Posterior pole view — 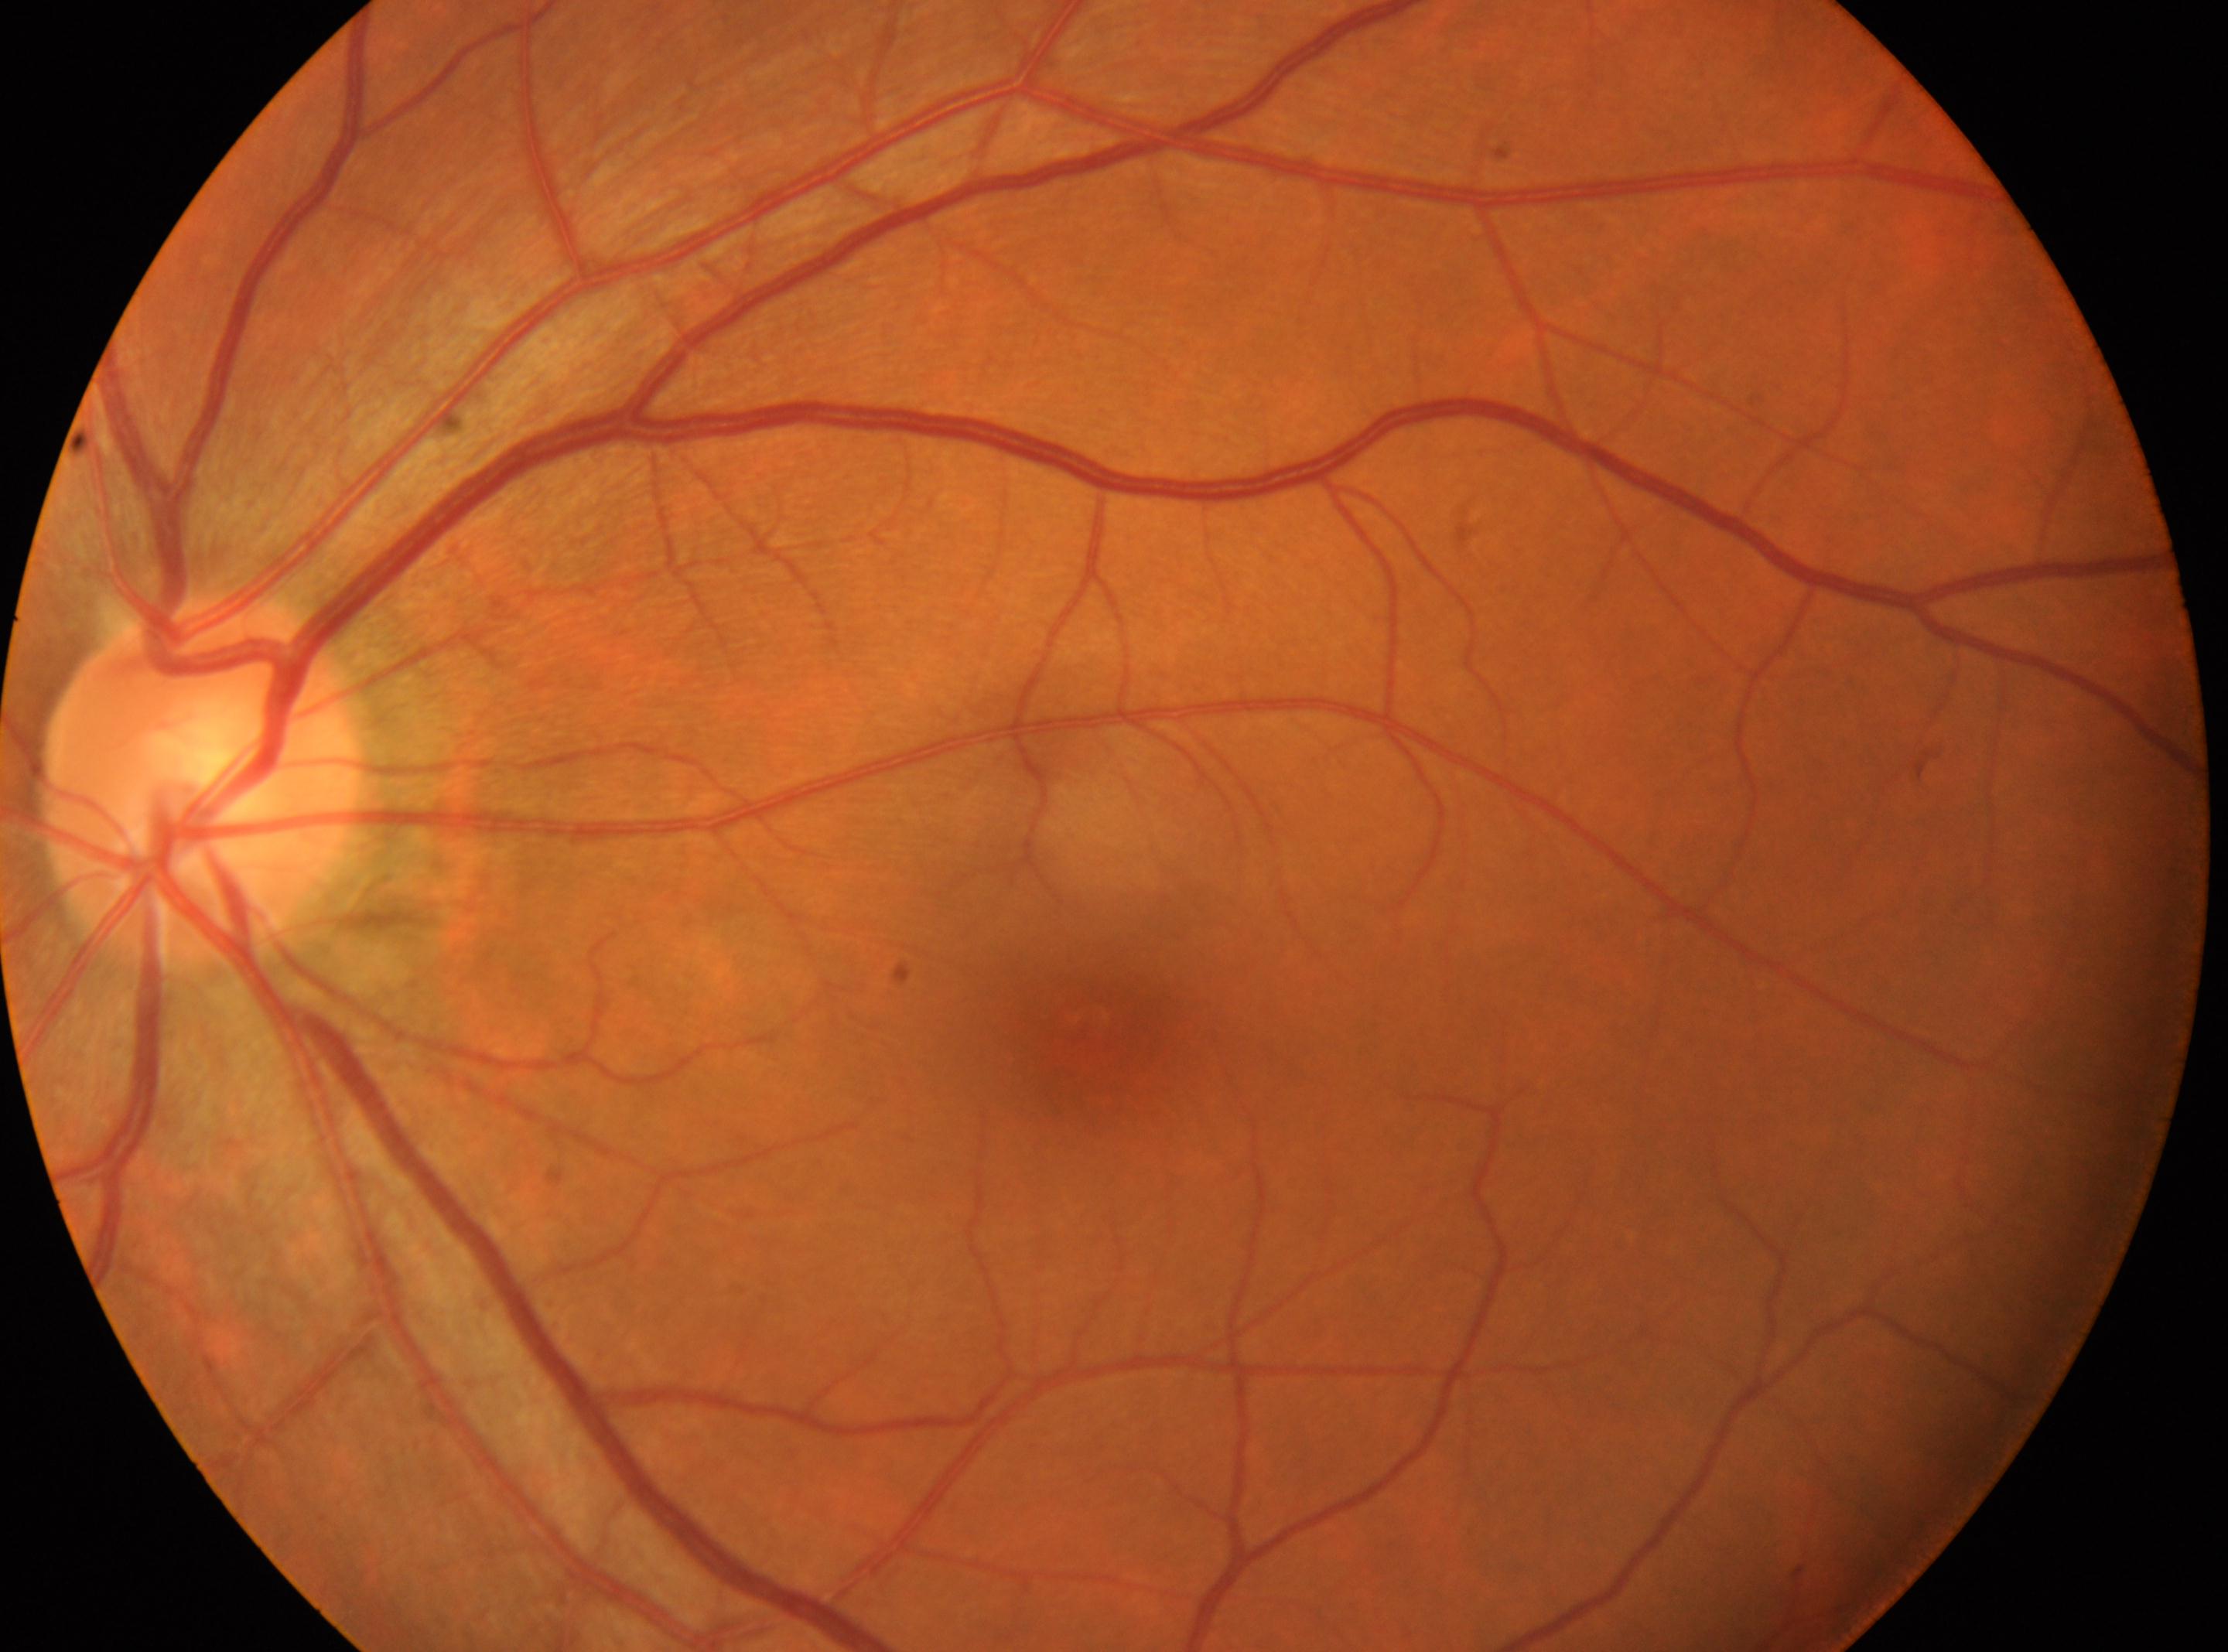 Findings:
* laterality: the left eye
* DR impression: No diabetic retinopathy identified
* fovea: (1086,1026)
* diabetic retinopathy (DR): no apparent retinopathy (grade 0)
* optic disc center: (203,783)